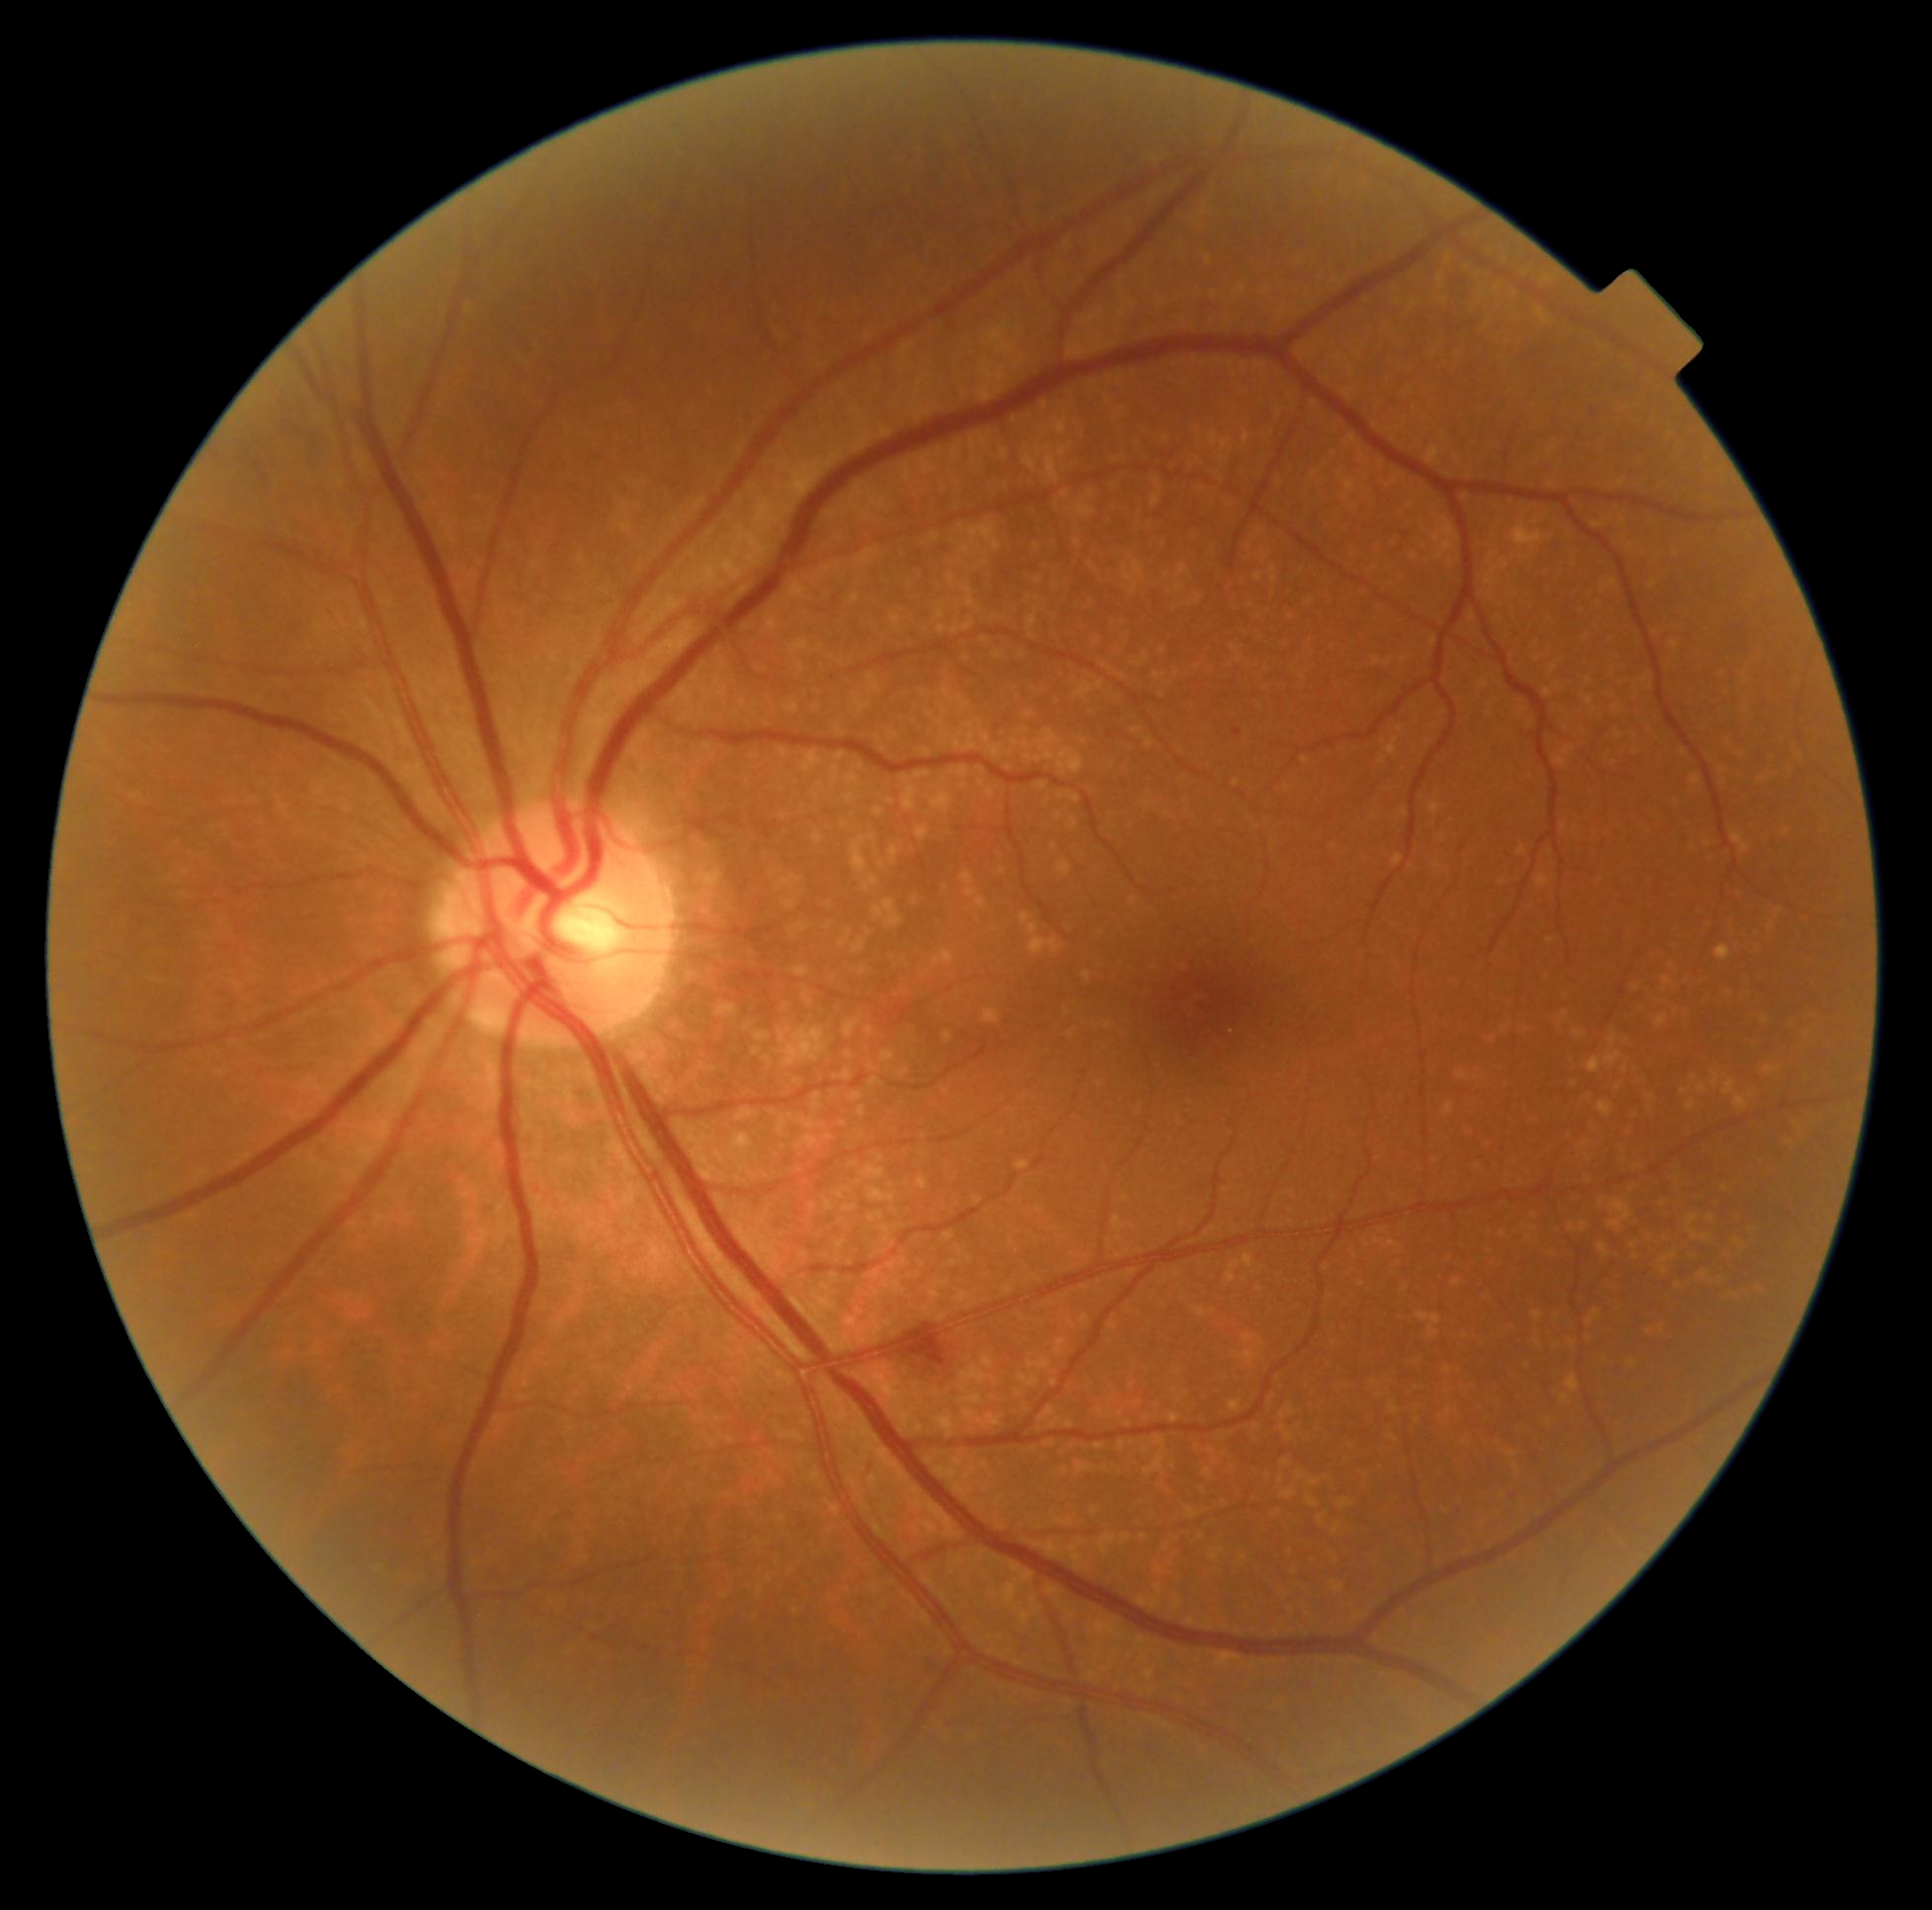
Diabetic retinopathy (DR): moderate non-proliferative diabetic retinopathy (grade 2).